1932 by 1932 pixels
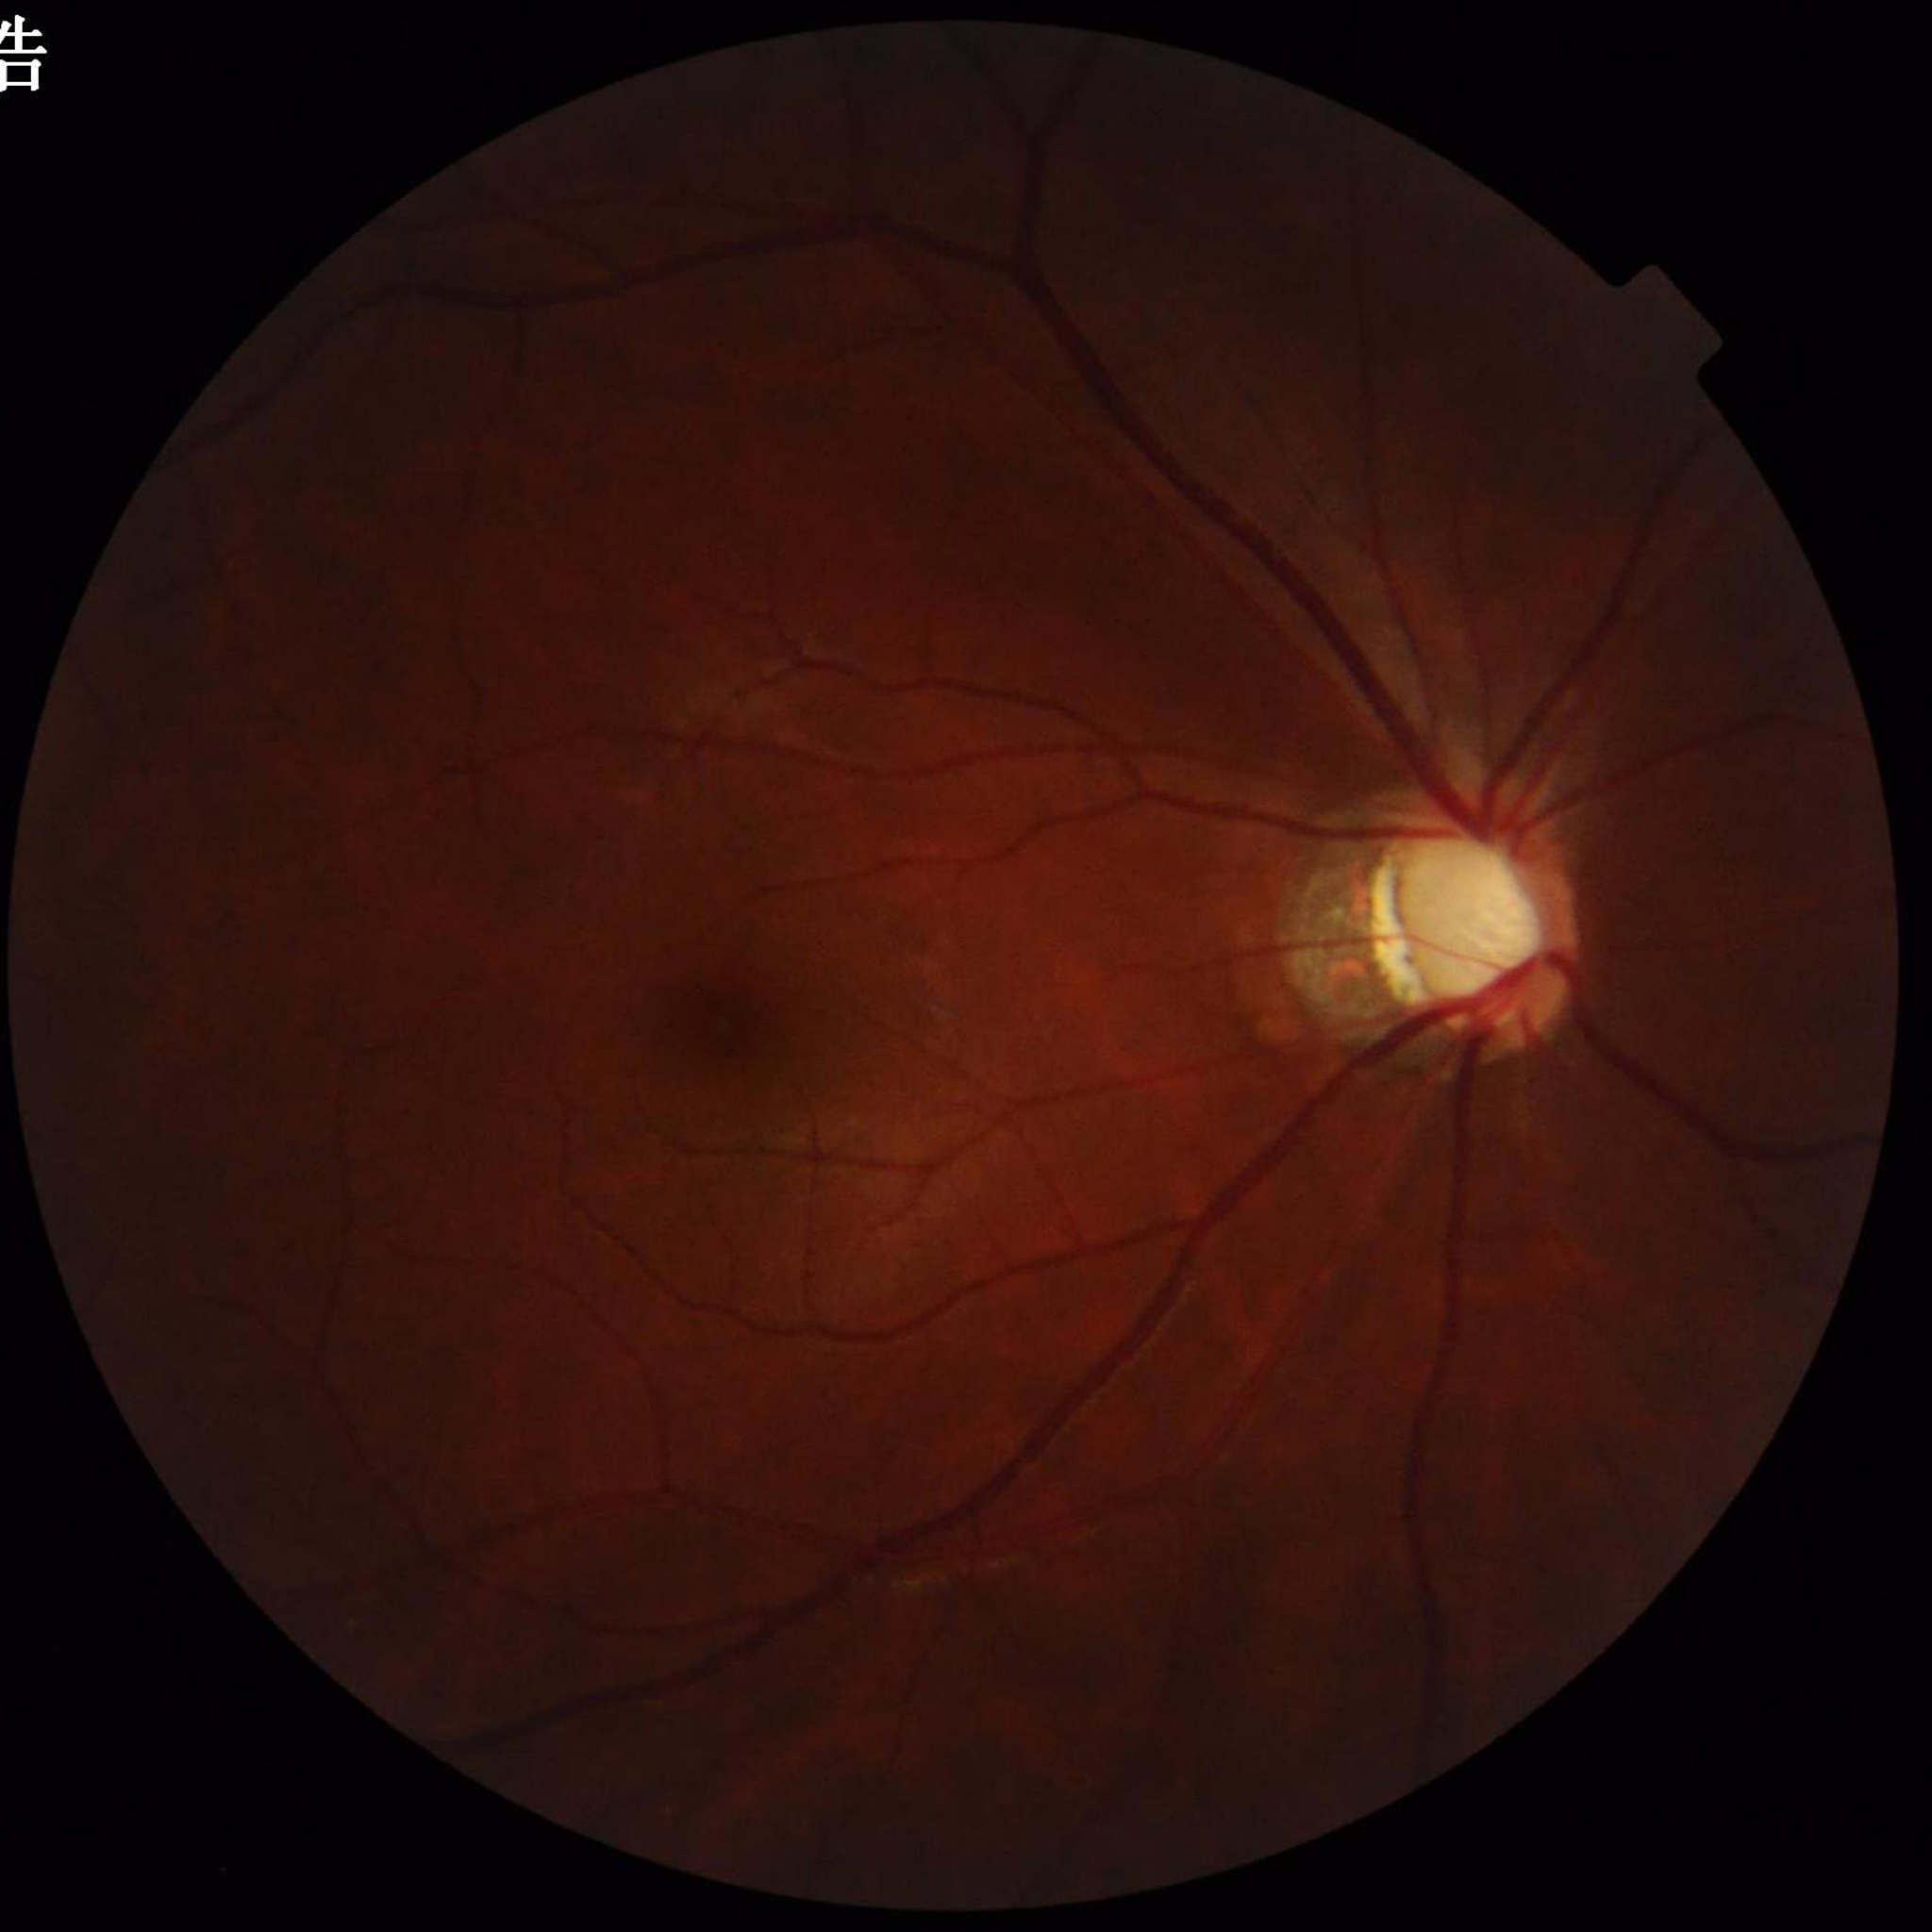 Photo quality: reduced — illumination/color distortion; Disease class: glaucoma.